848x848px — 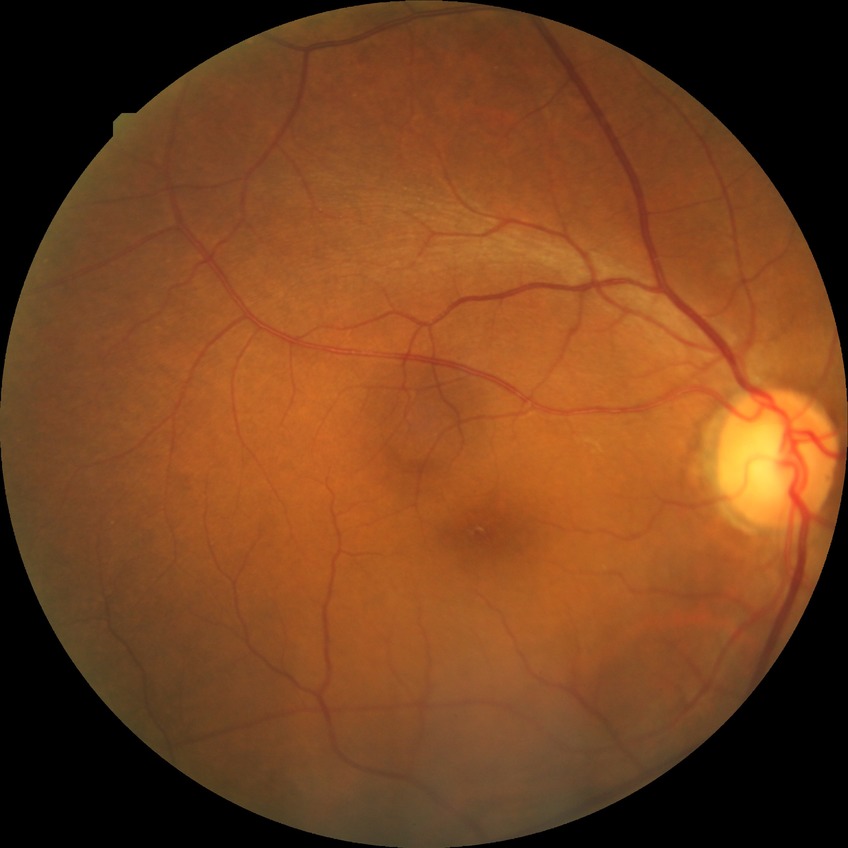
Diabetic retinopathy (DR) is simple diabetic retinopathy (SDR).